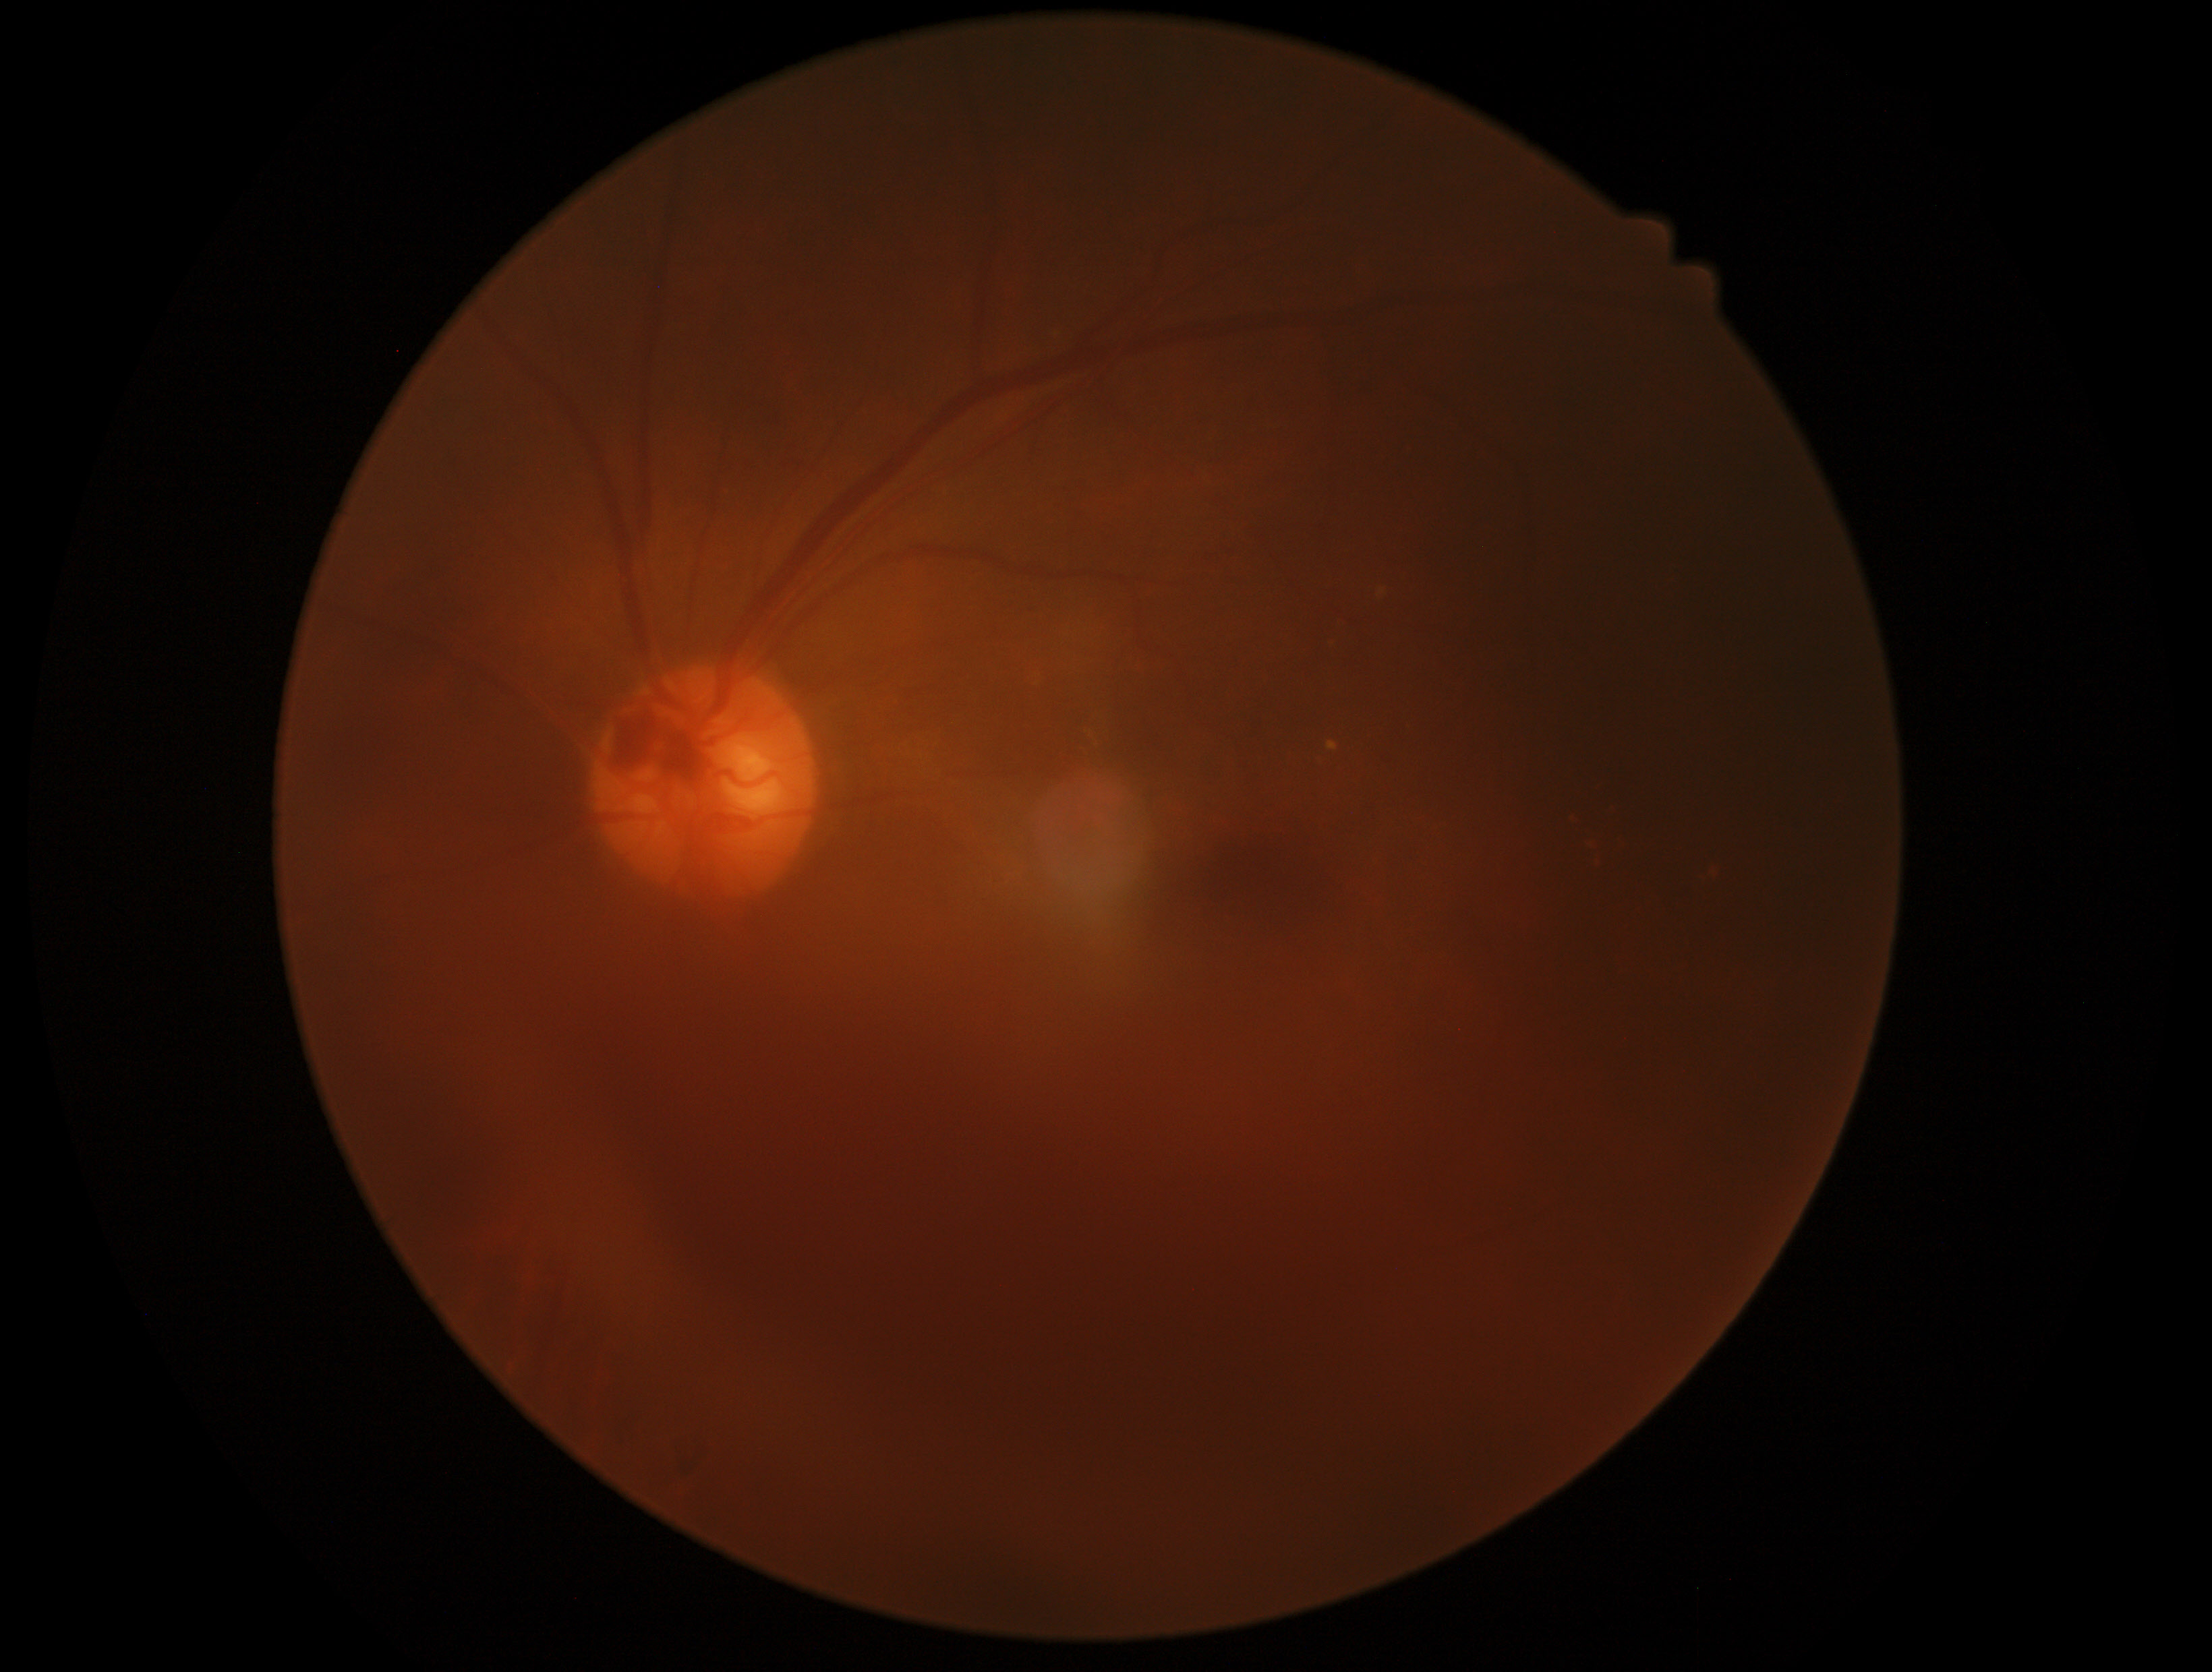 DR is 4.